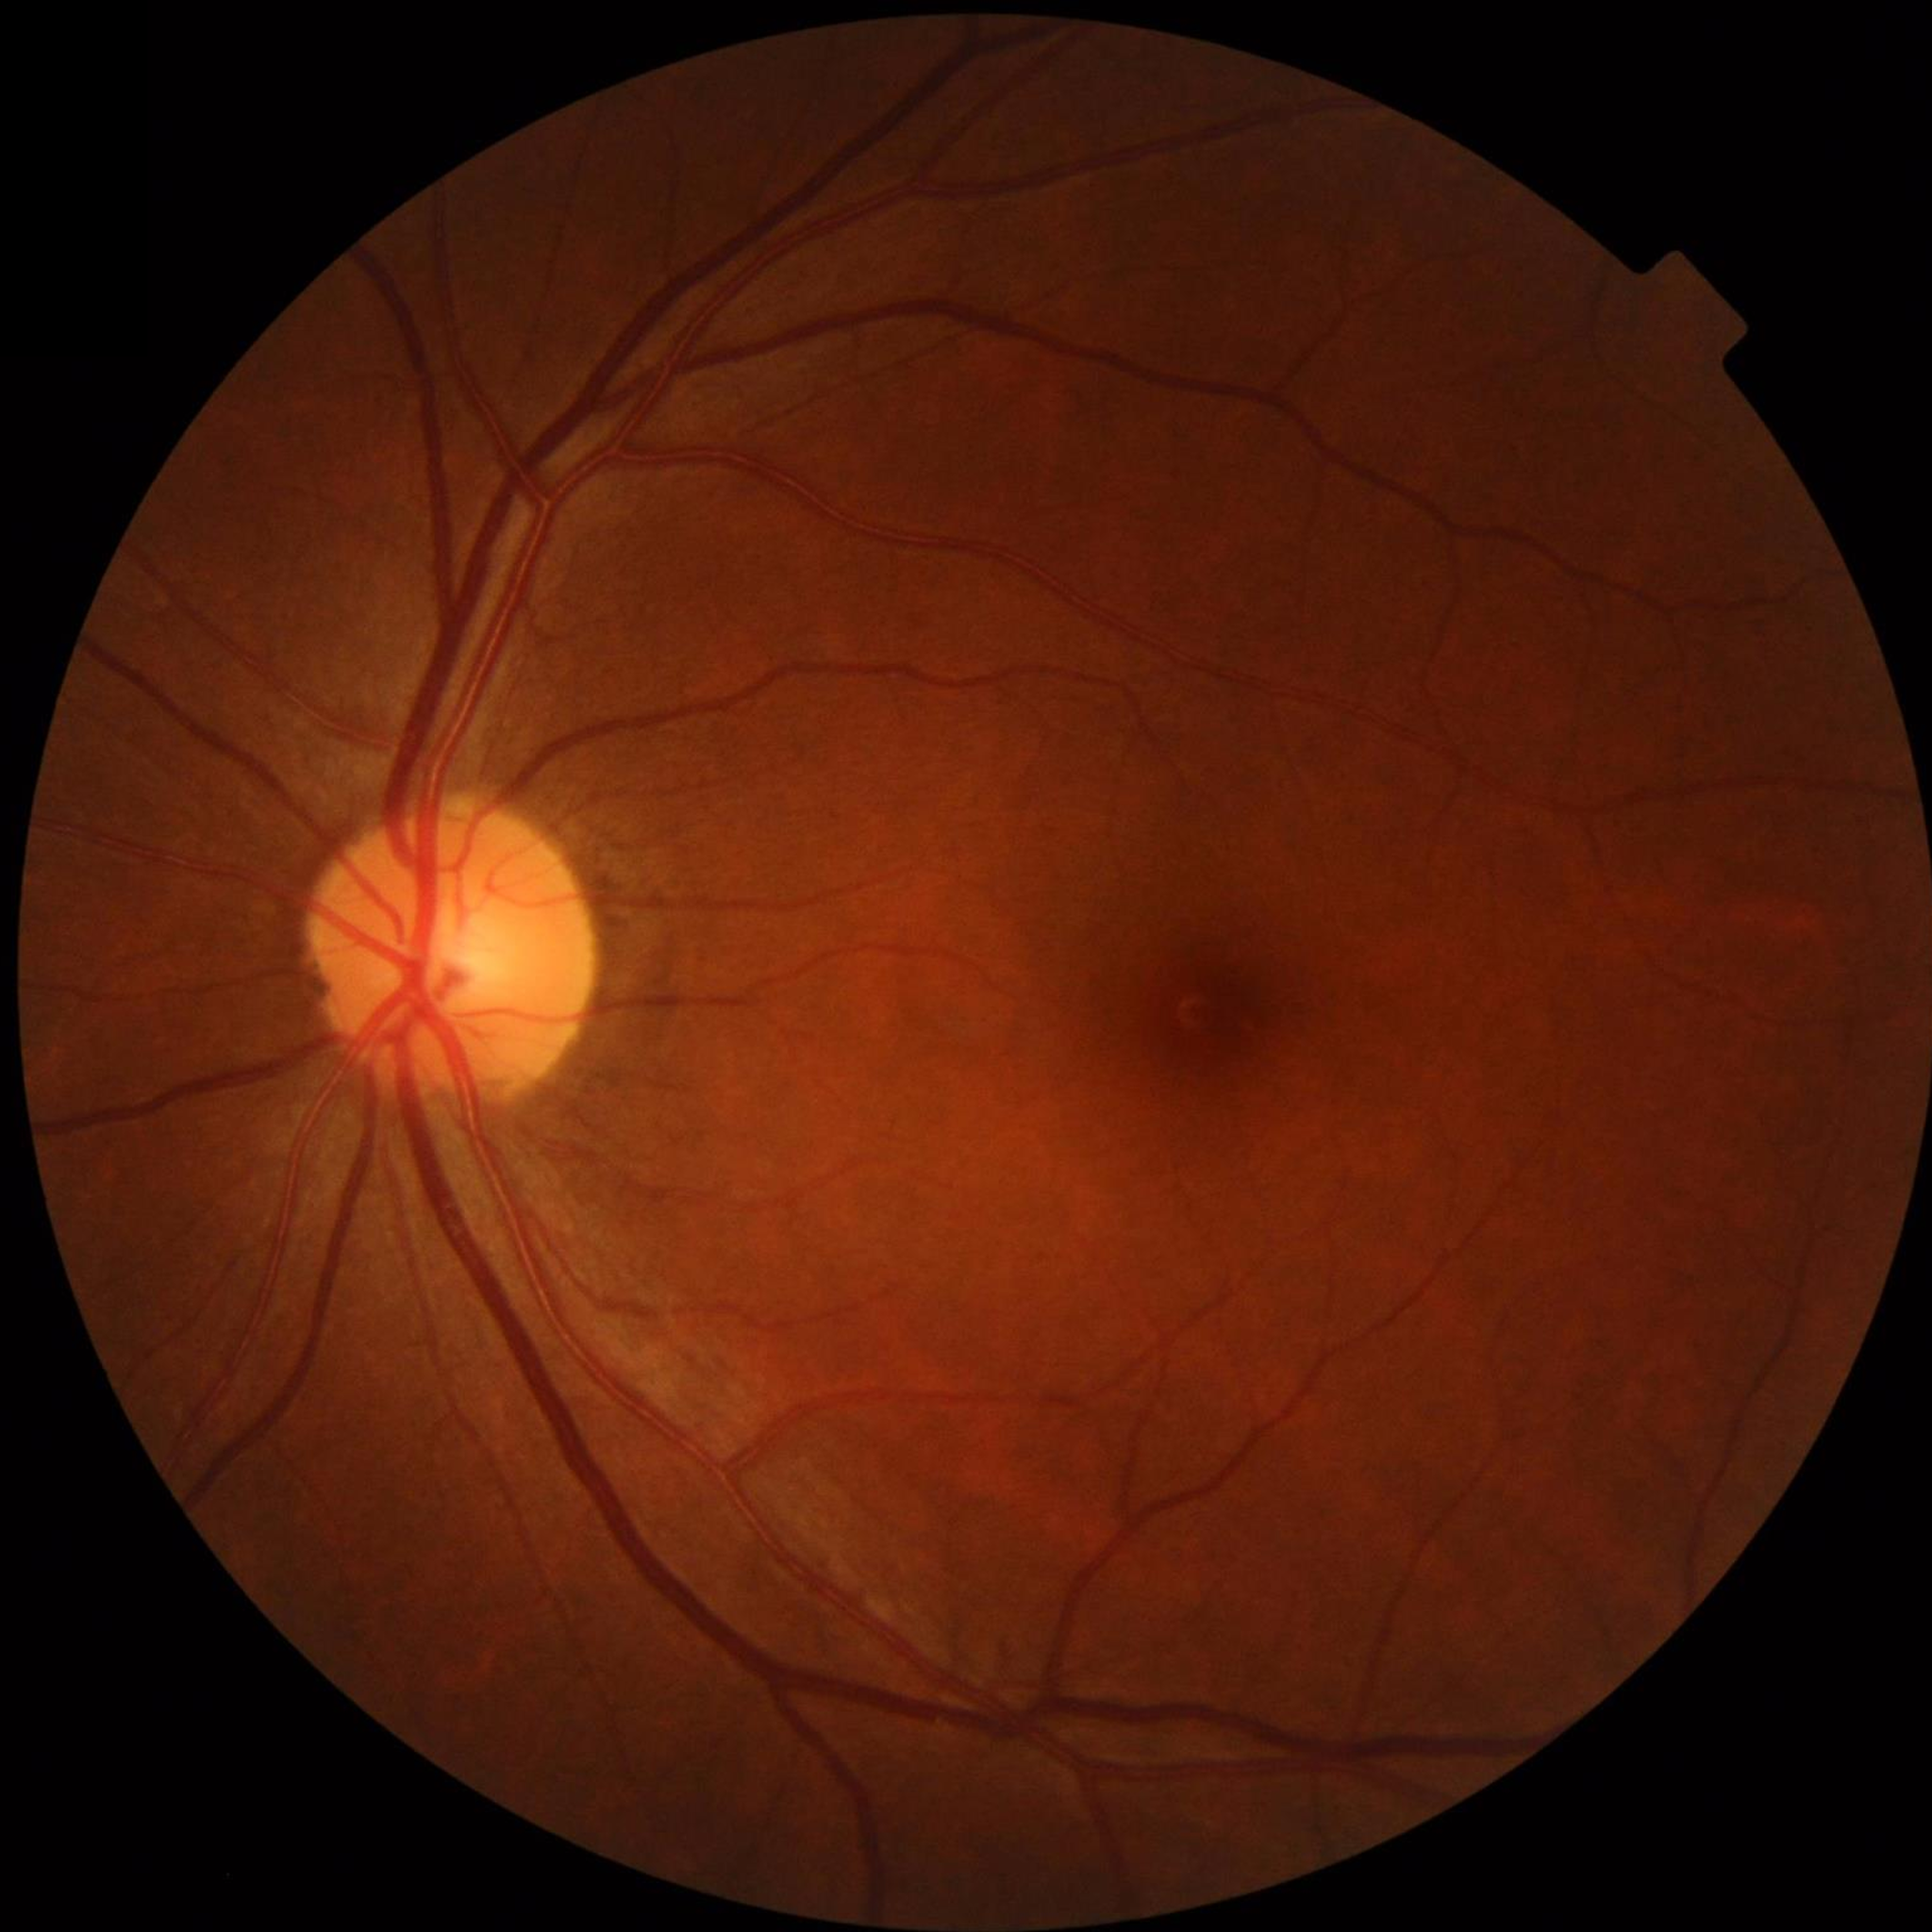 Quality: no blur, illumination and color satisfactory, contrast adequate | Disease class: no AMD, diabetic retinopathy, or glaucoma.